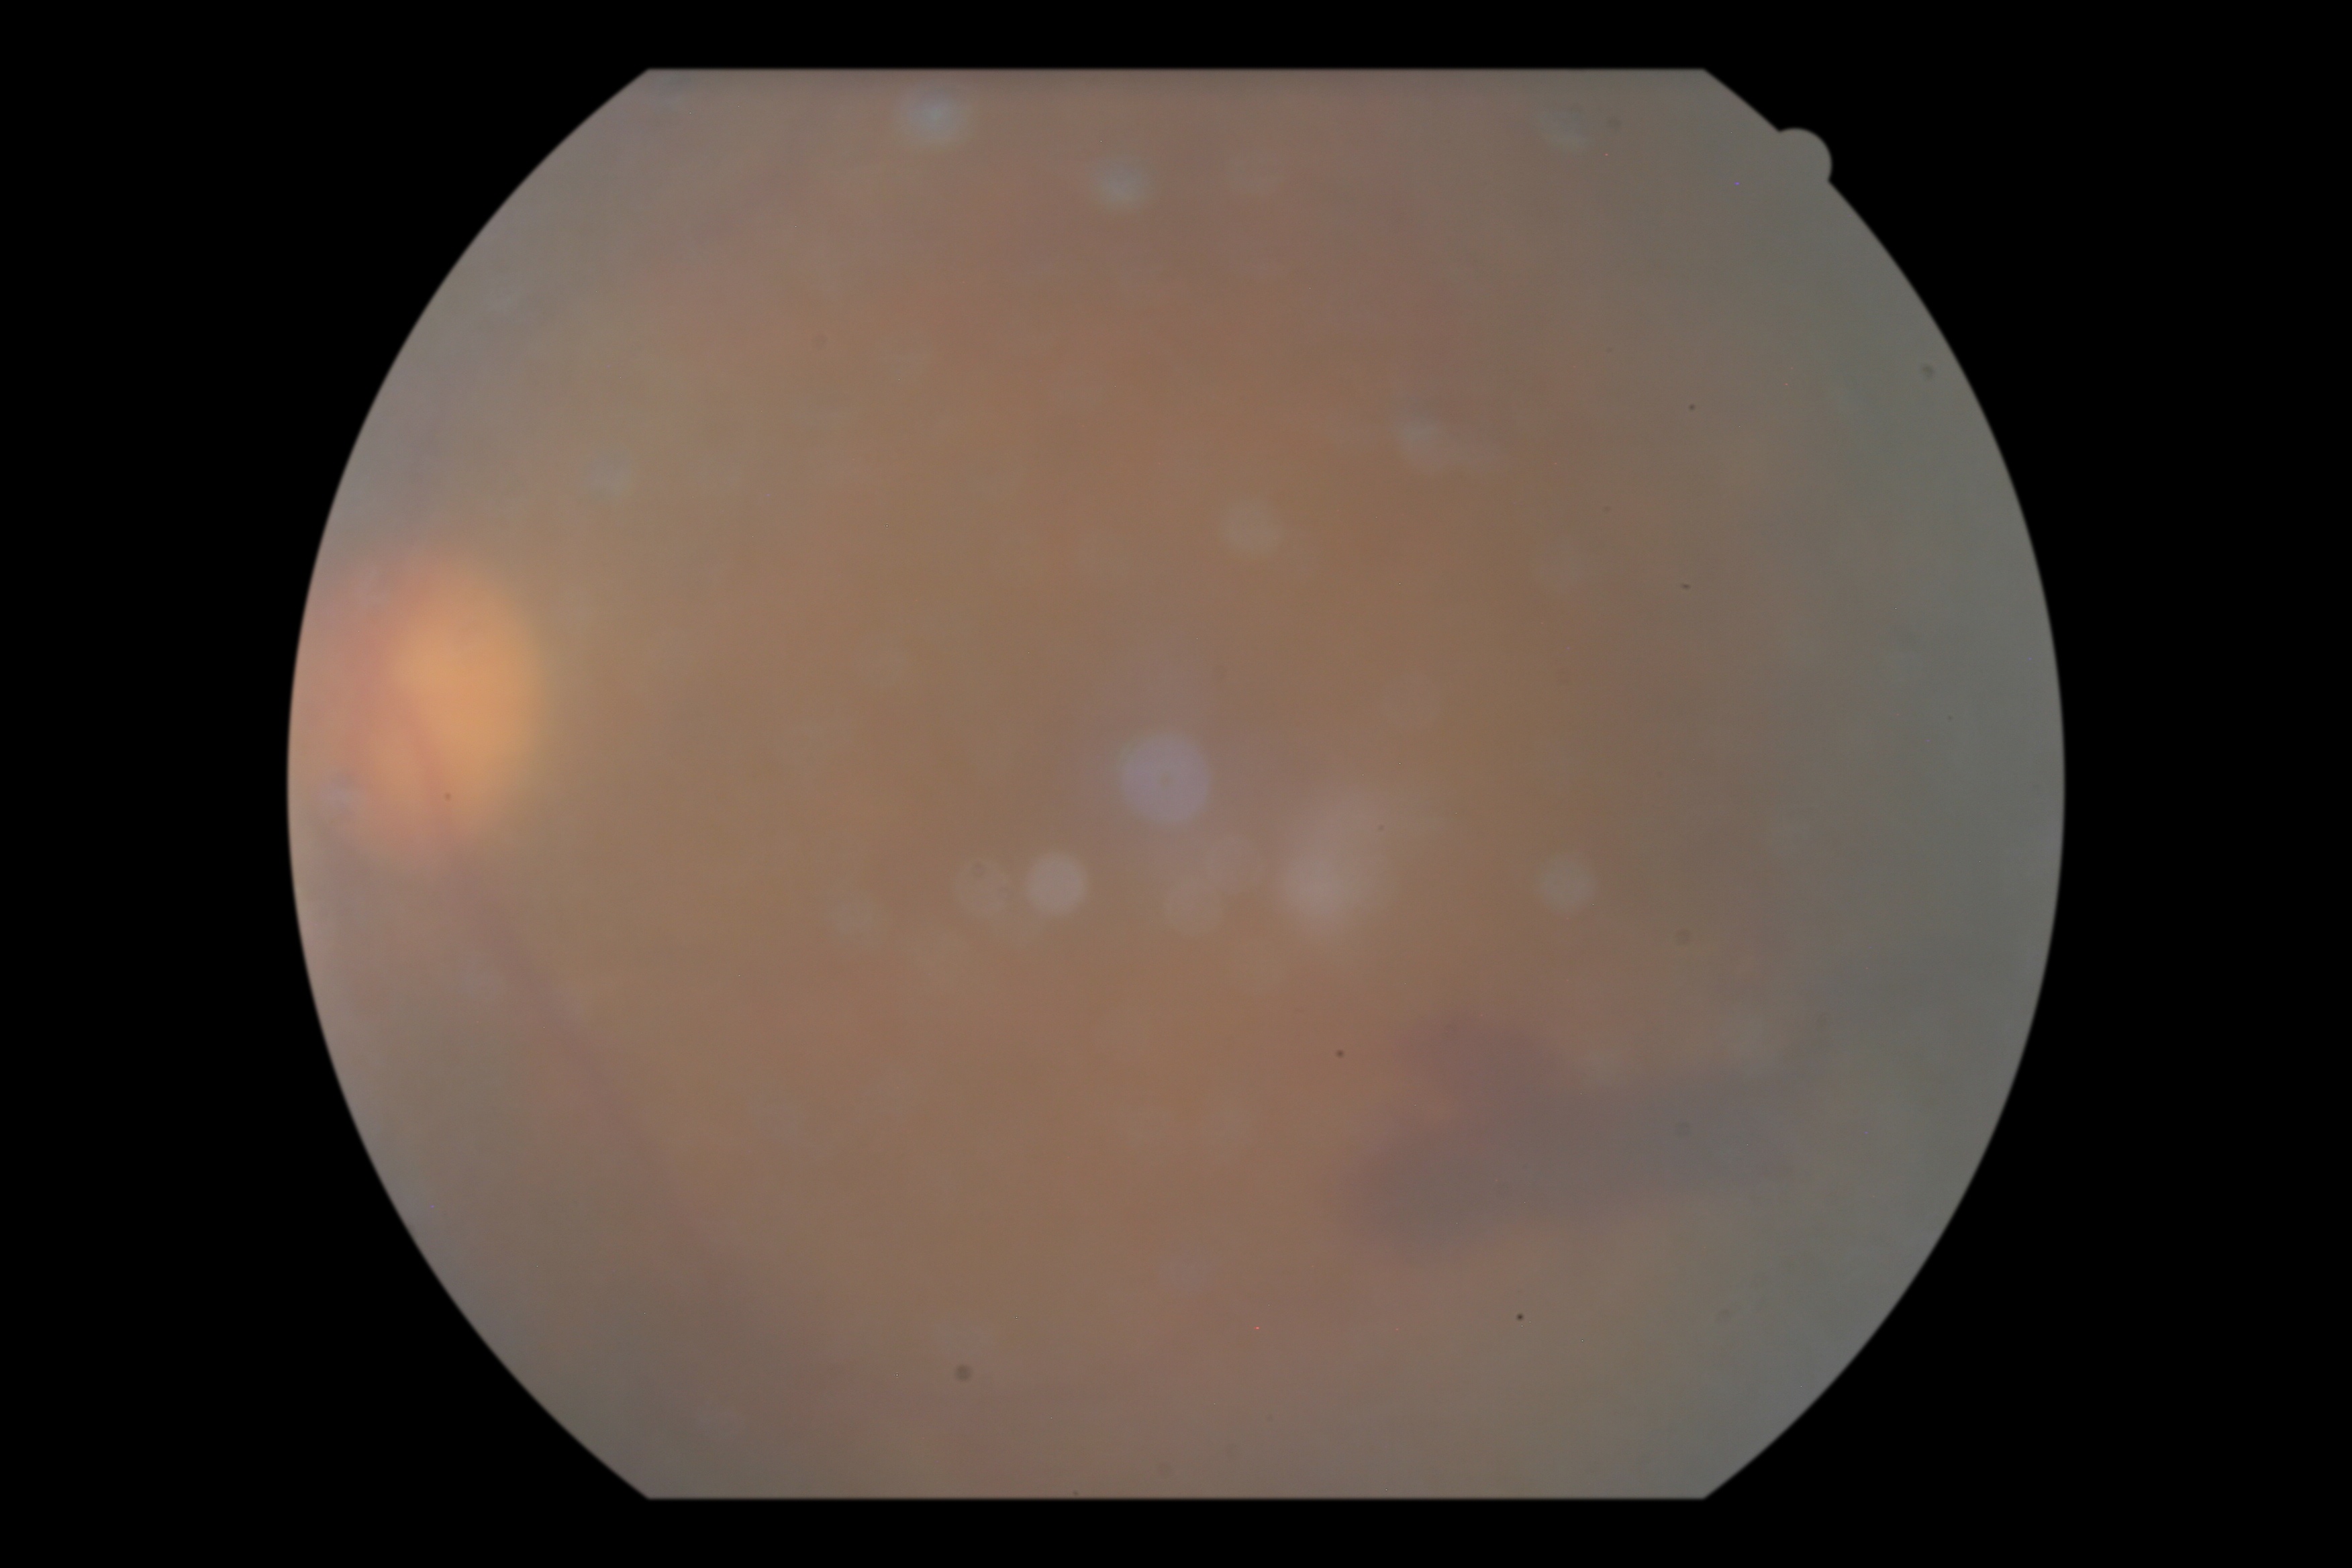

Diabetic retinopathy severity is grade 4.